Topcon TRC-50DX, posterior pole view:
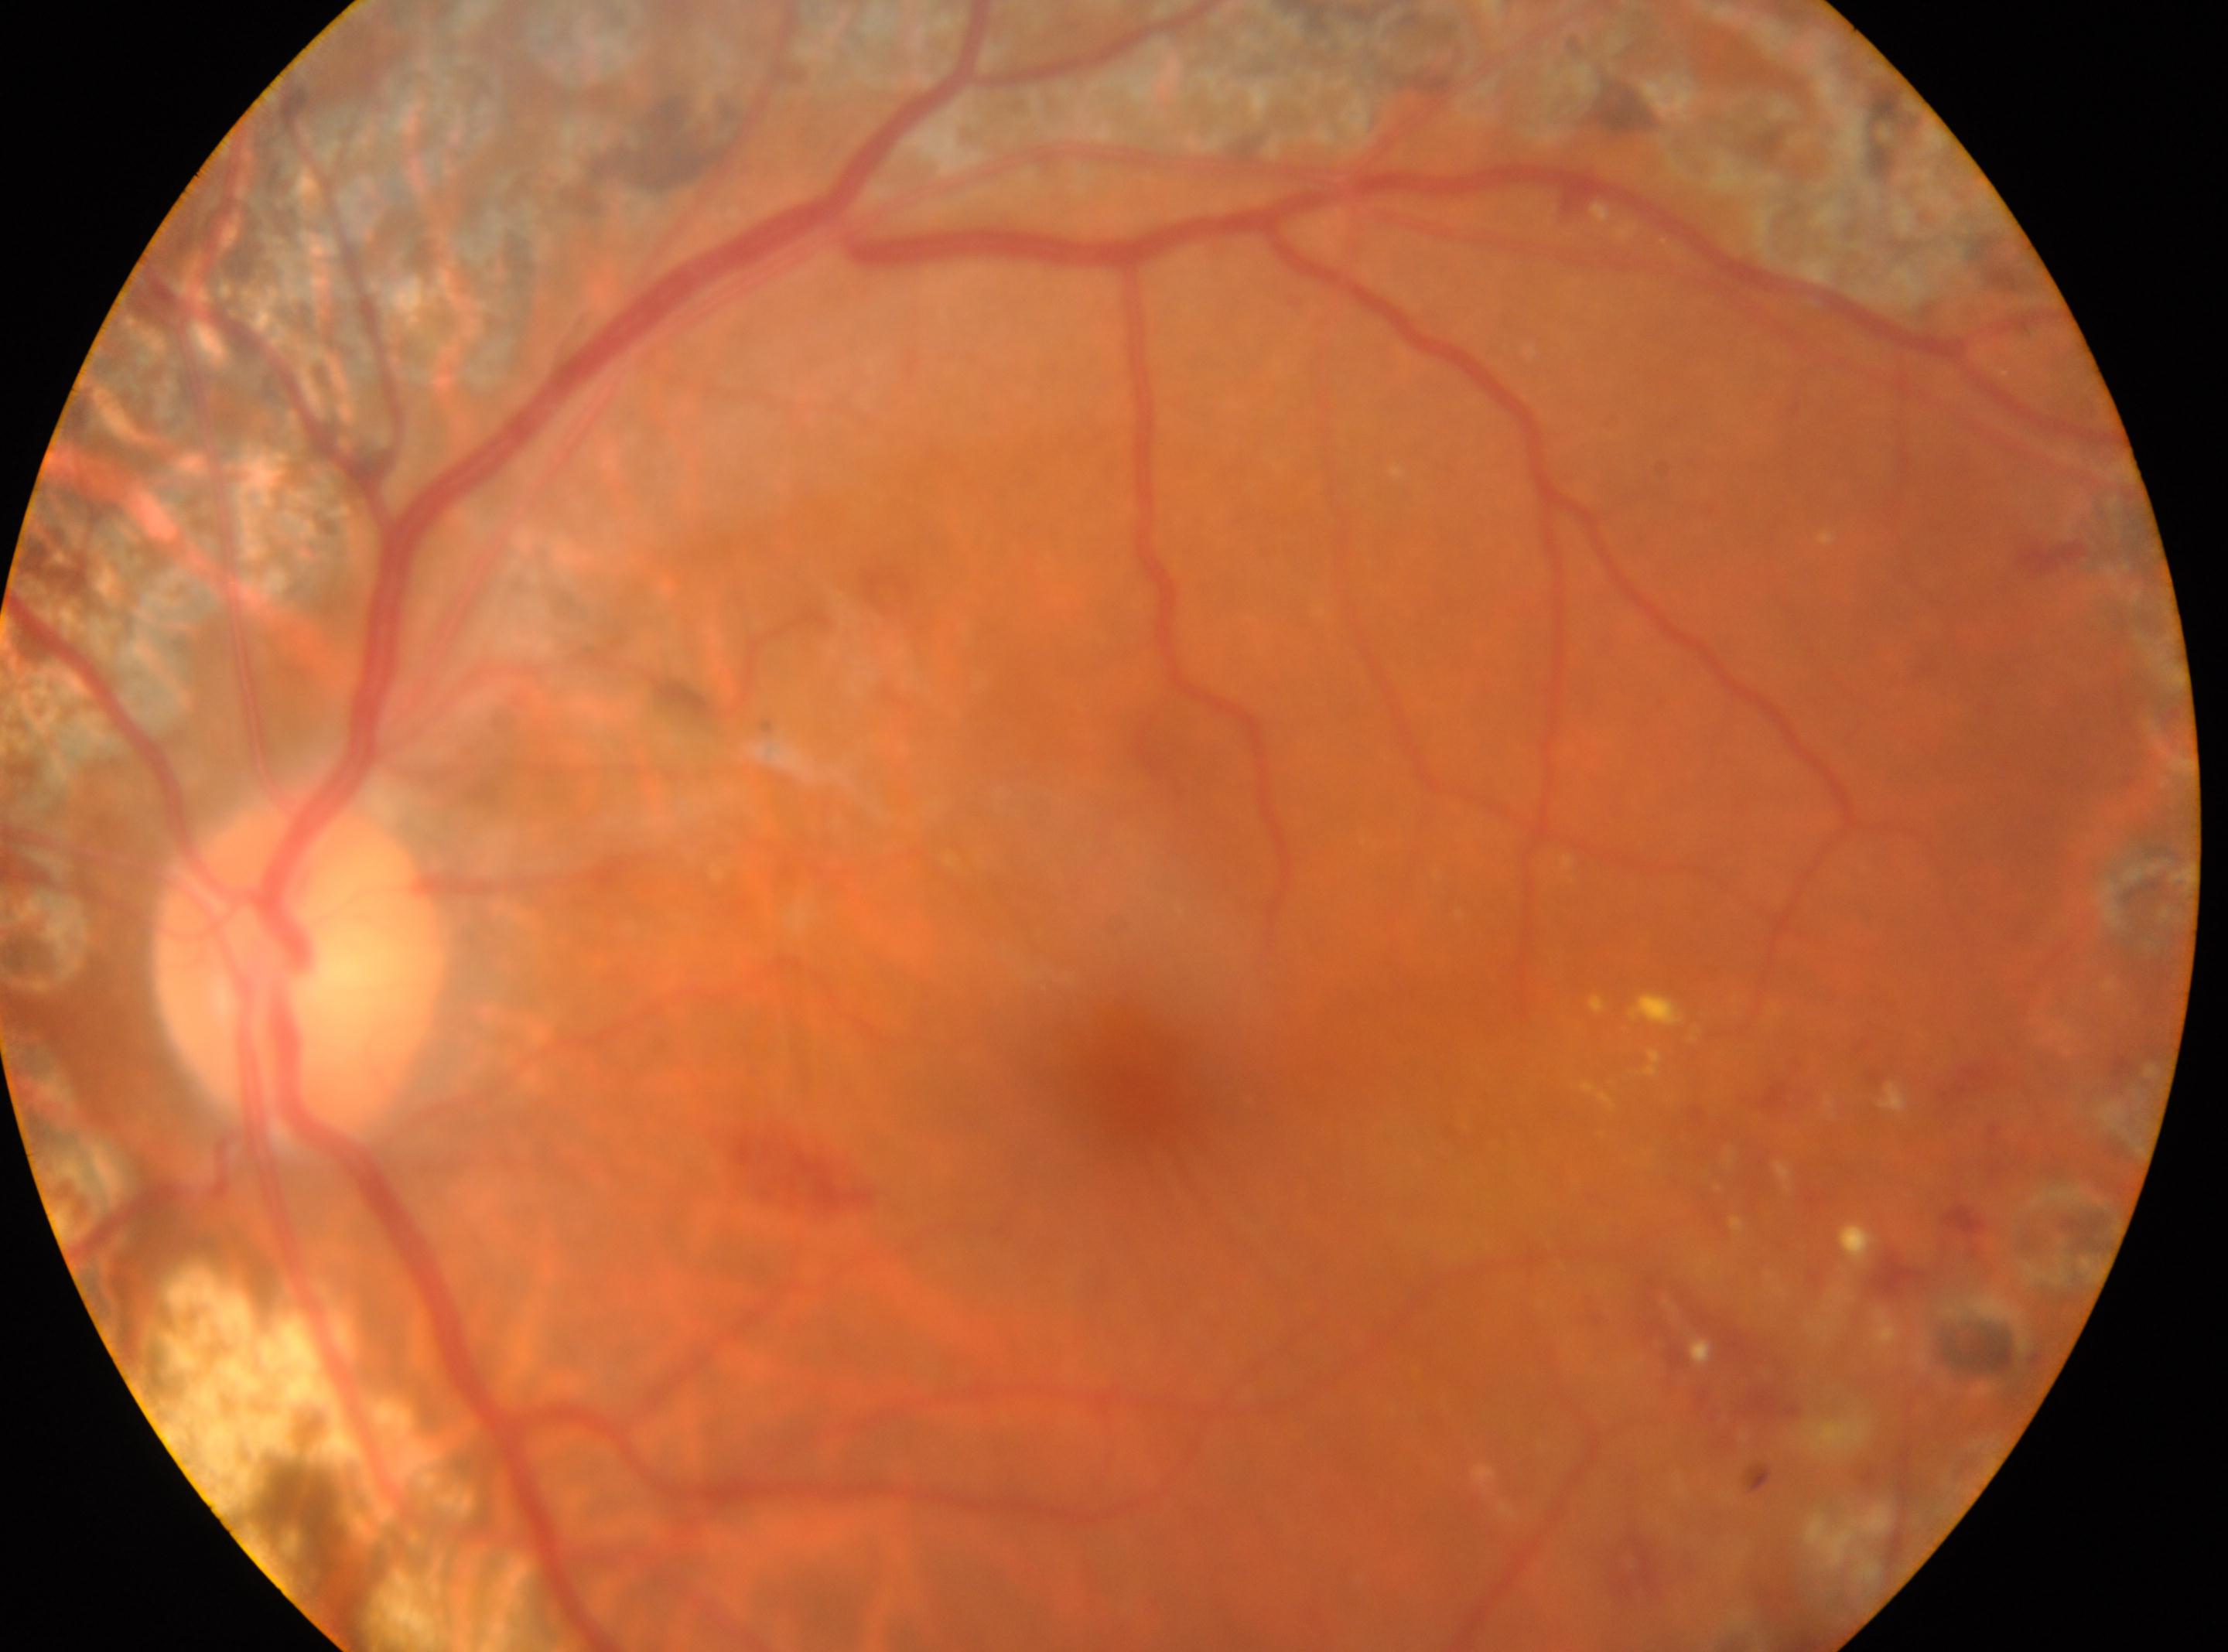

fovea: 1119px, 1084px
optic_disc: 297px, 967px
dr_grade: laser-treated DR, underlying severity PDR (grade 4)
eye: oculus sinister